Disc-centered field: 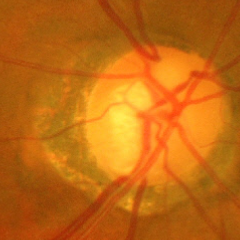

Findings consistent with glaucoma. Diagnosis: severe glaucomatous damage.